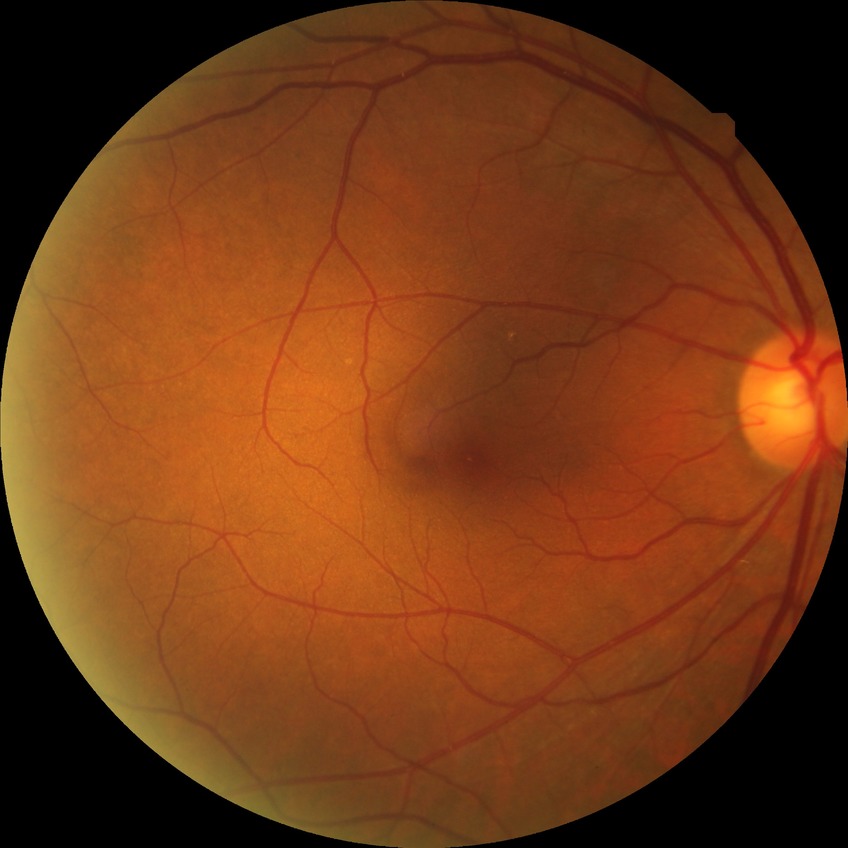
Diabetic retinopathy grade: no diabetic retinopathy.